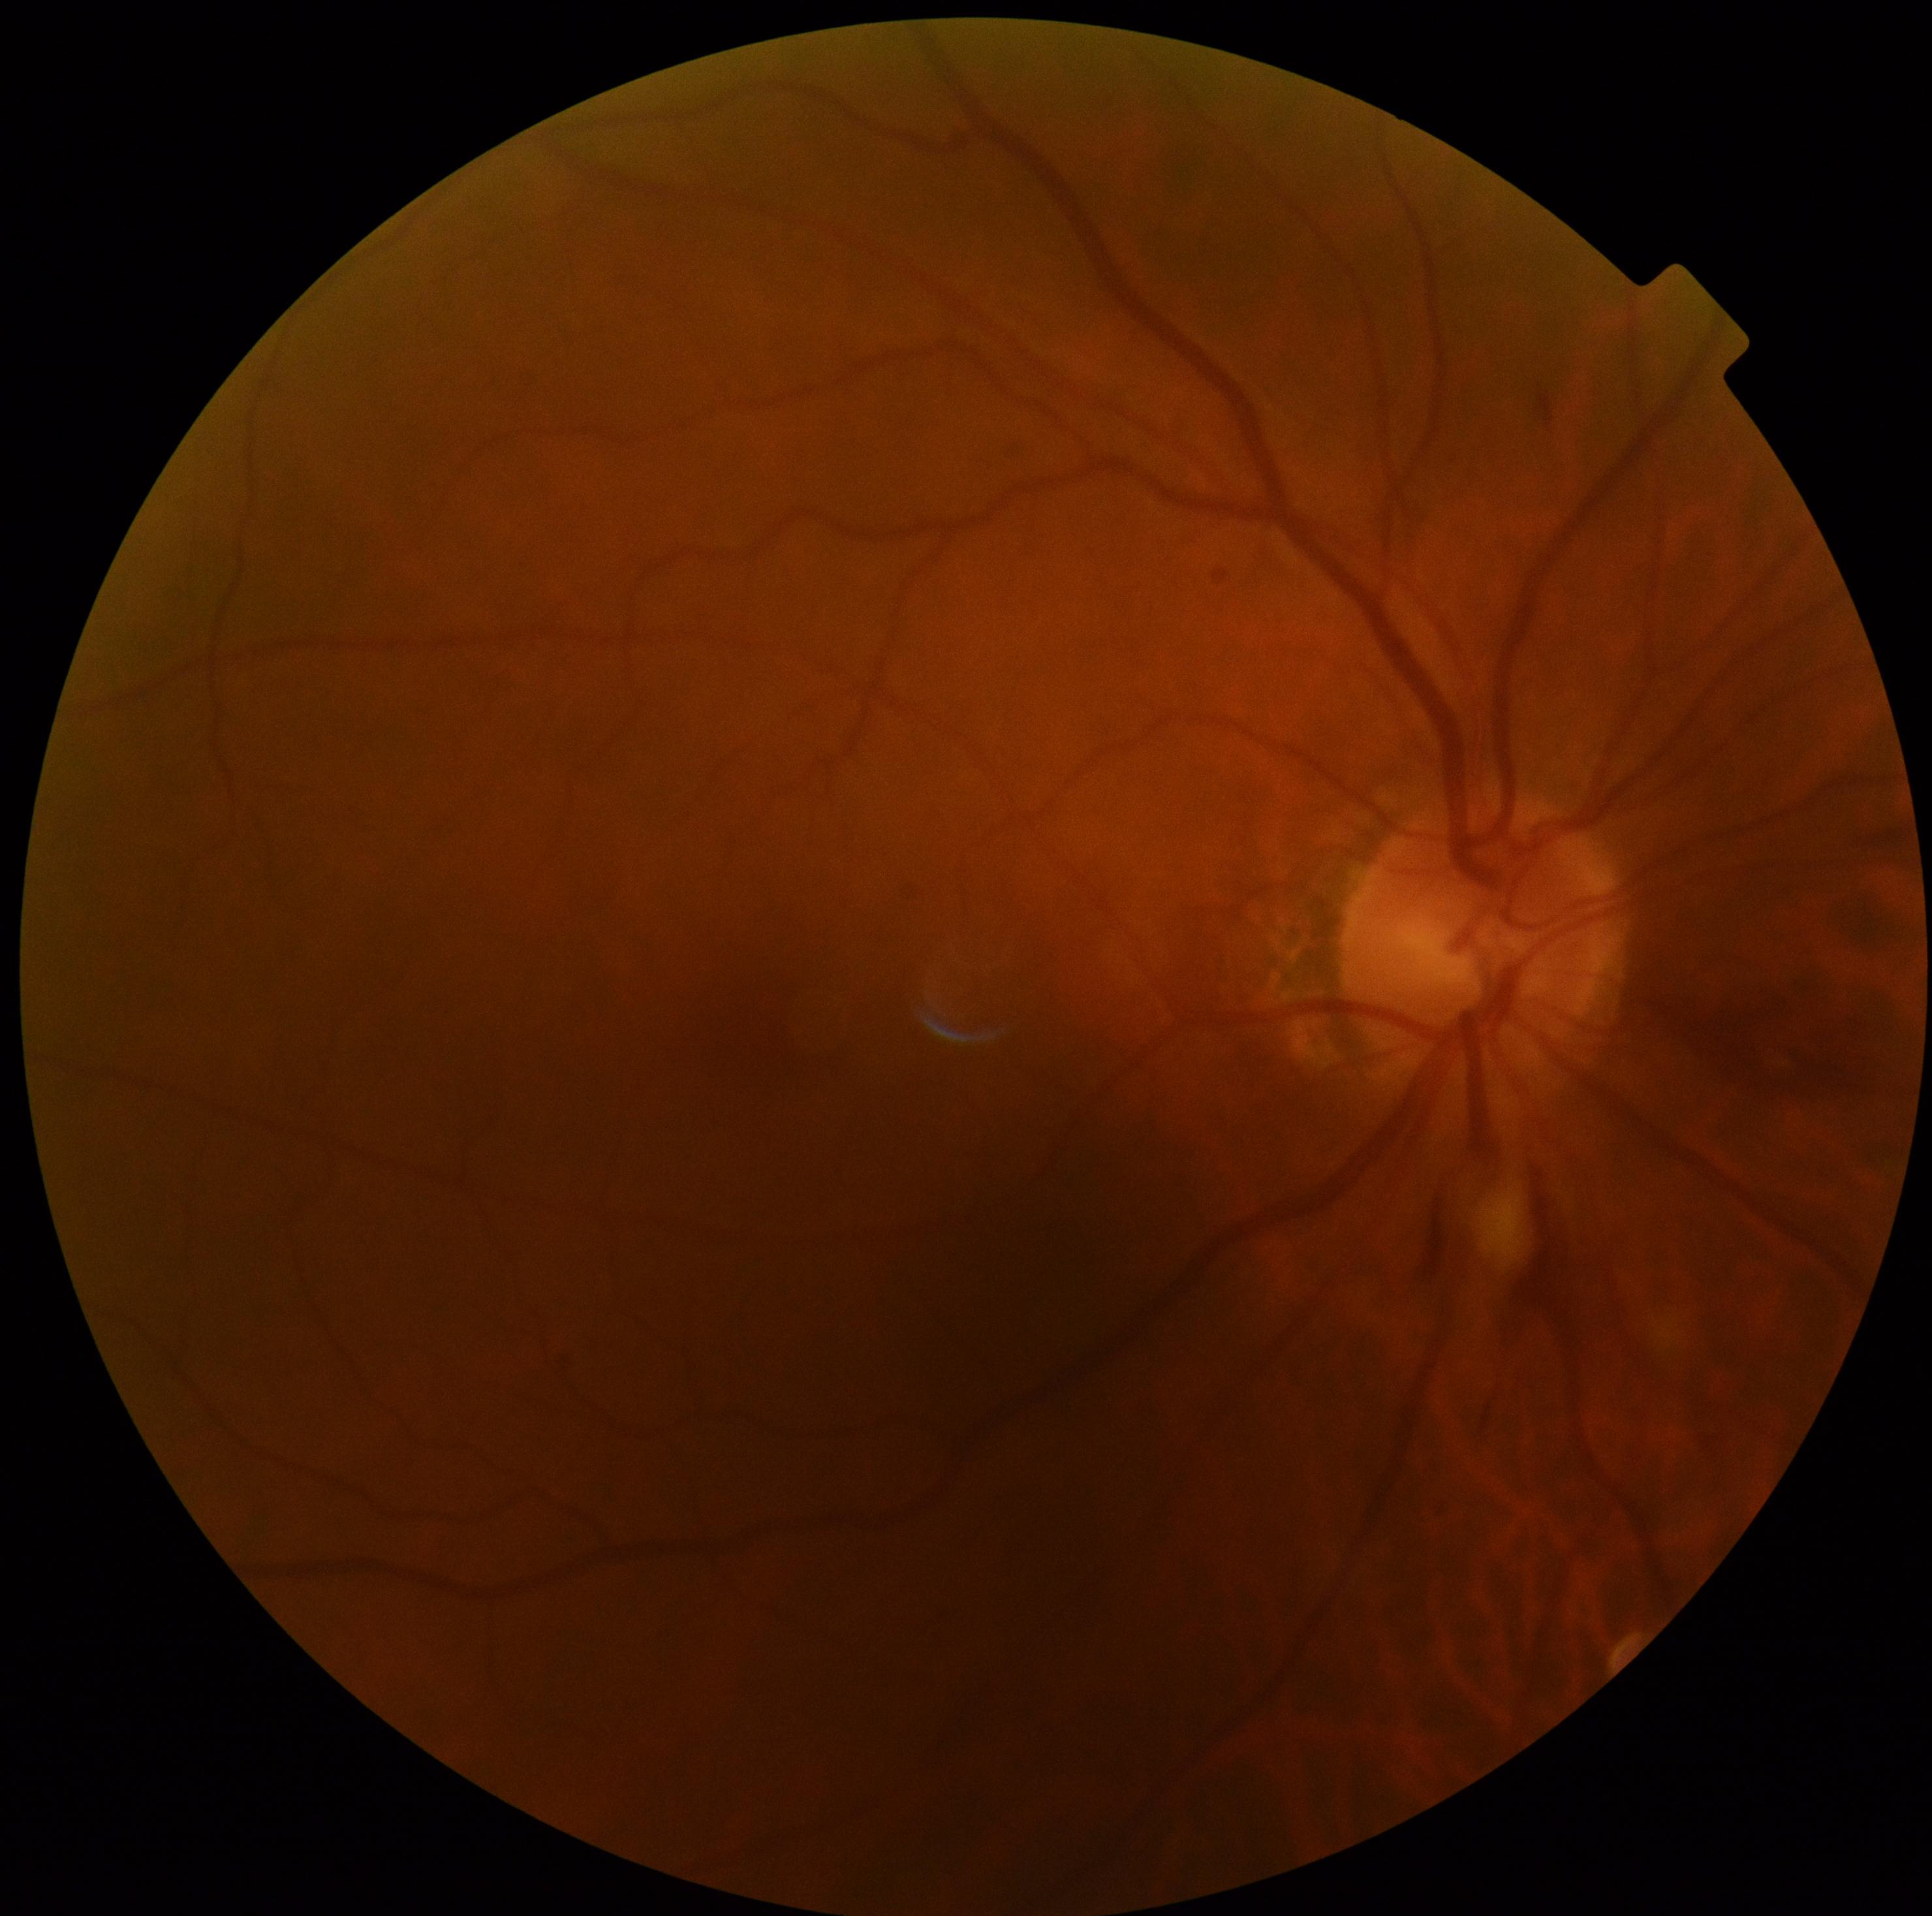

{"dr_grade": "grade 2"}